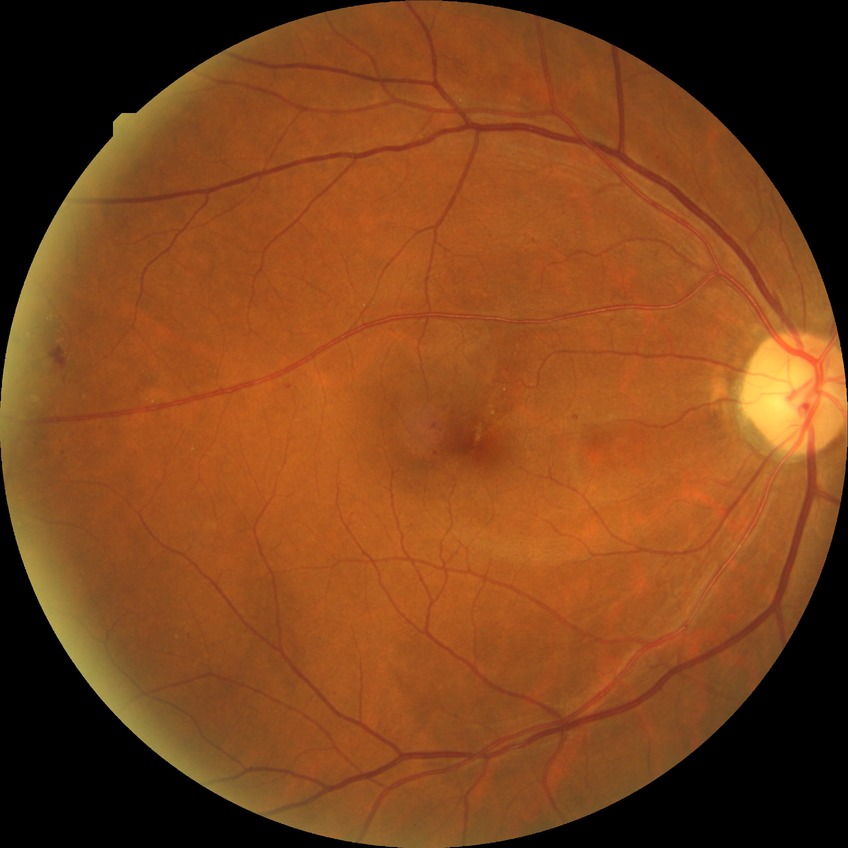

Diabetic retinopathy (DR): proliferative diabetic retinopathy (PDR).